Infant wide-field fundus photograph
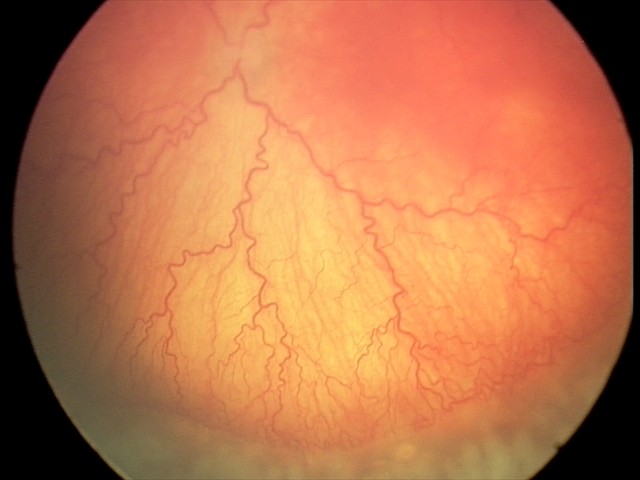 Impression: plus disease — abnormal dilation and tortuosity of the posterior pole retinal vessels | aggressive ROP (A-ROP).